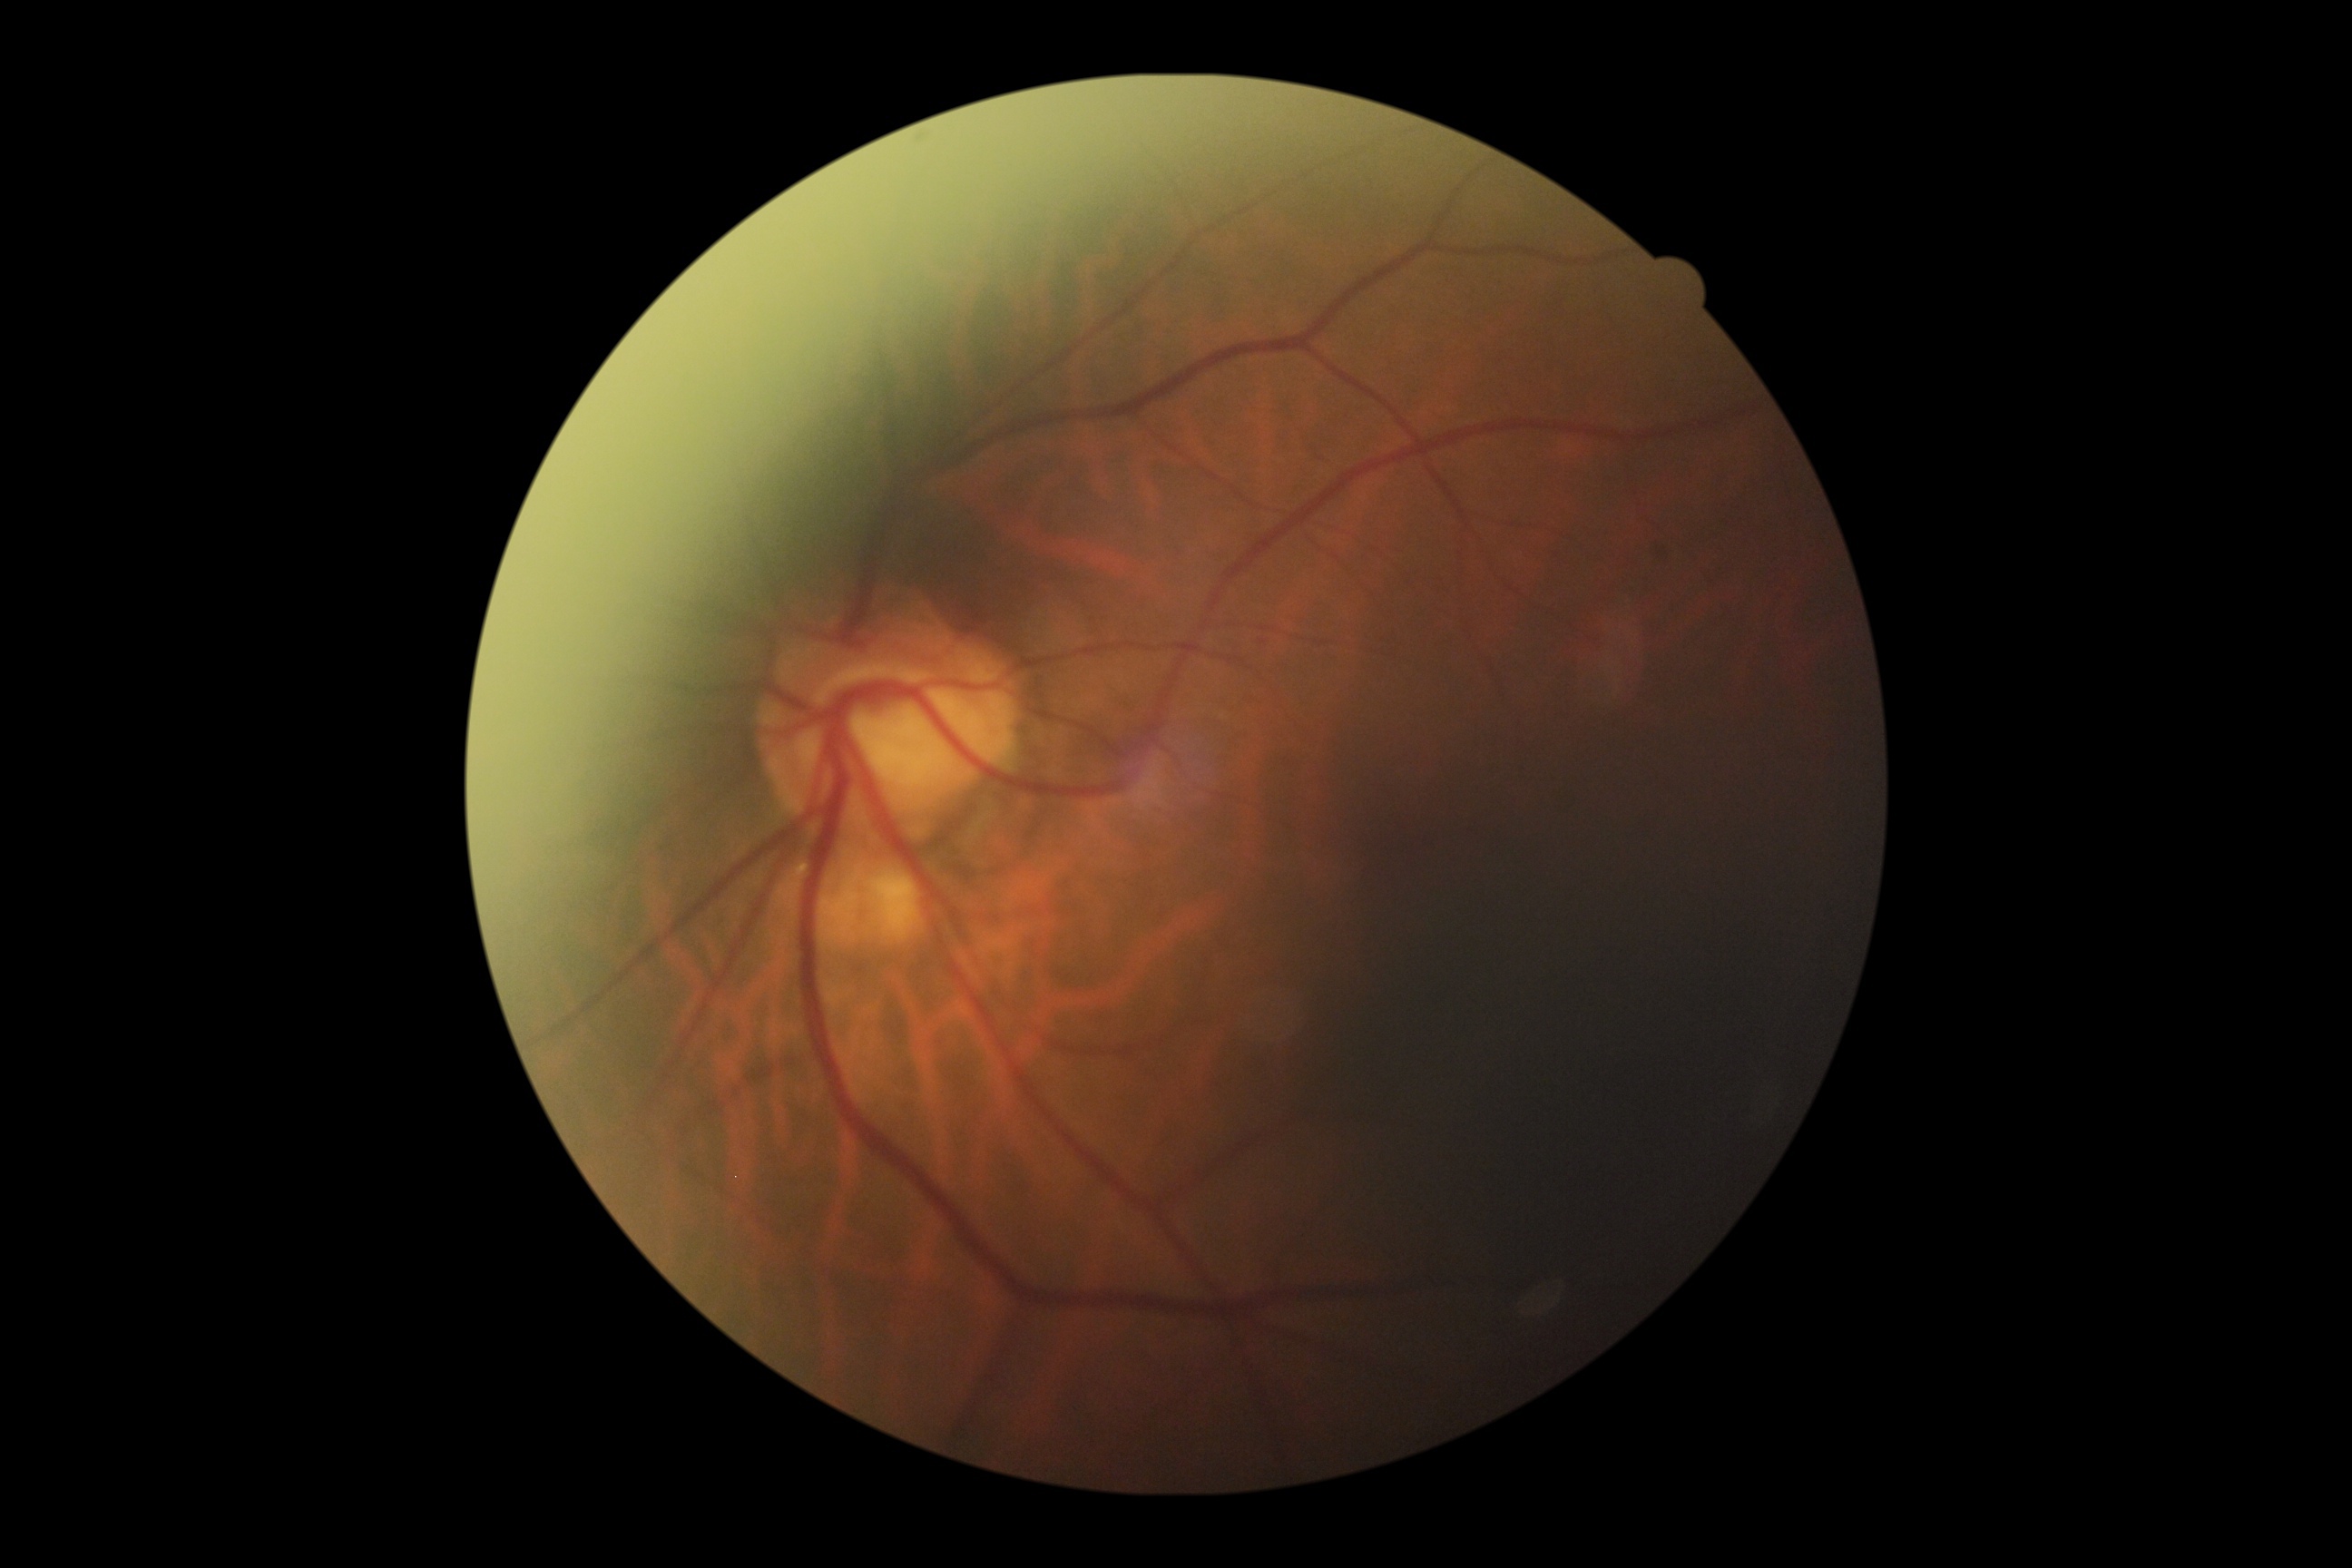

* diabetic retinopathy — moderate NPDR (grade 2)